Color fundus image — 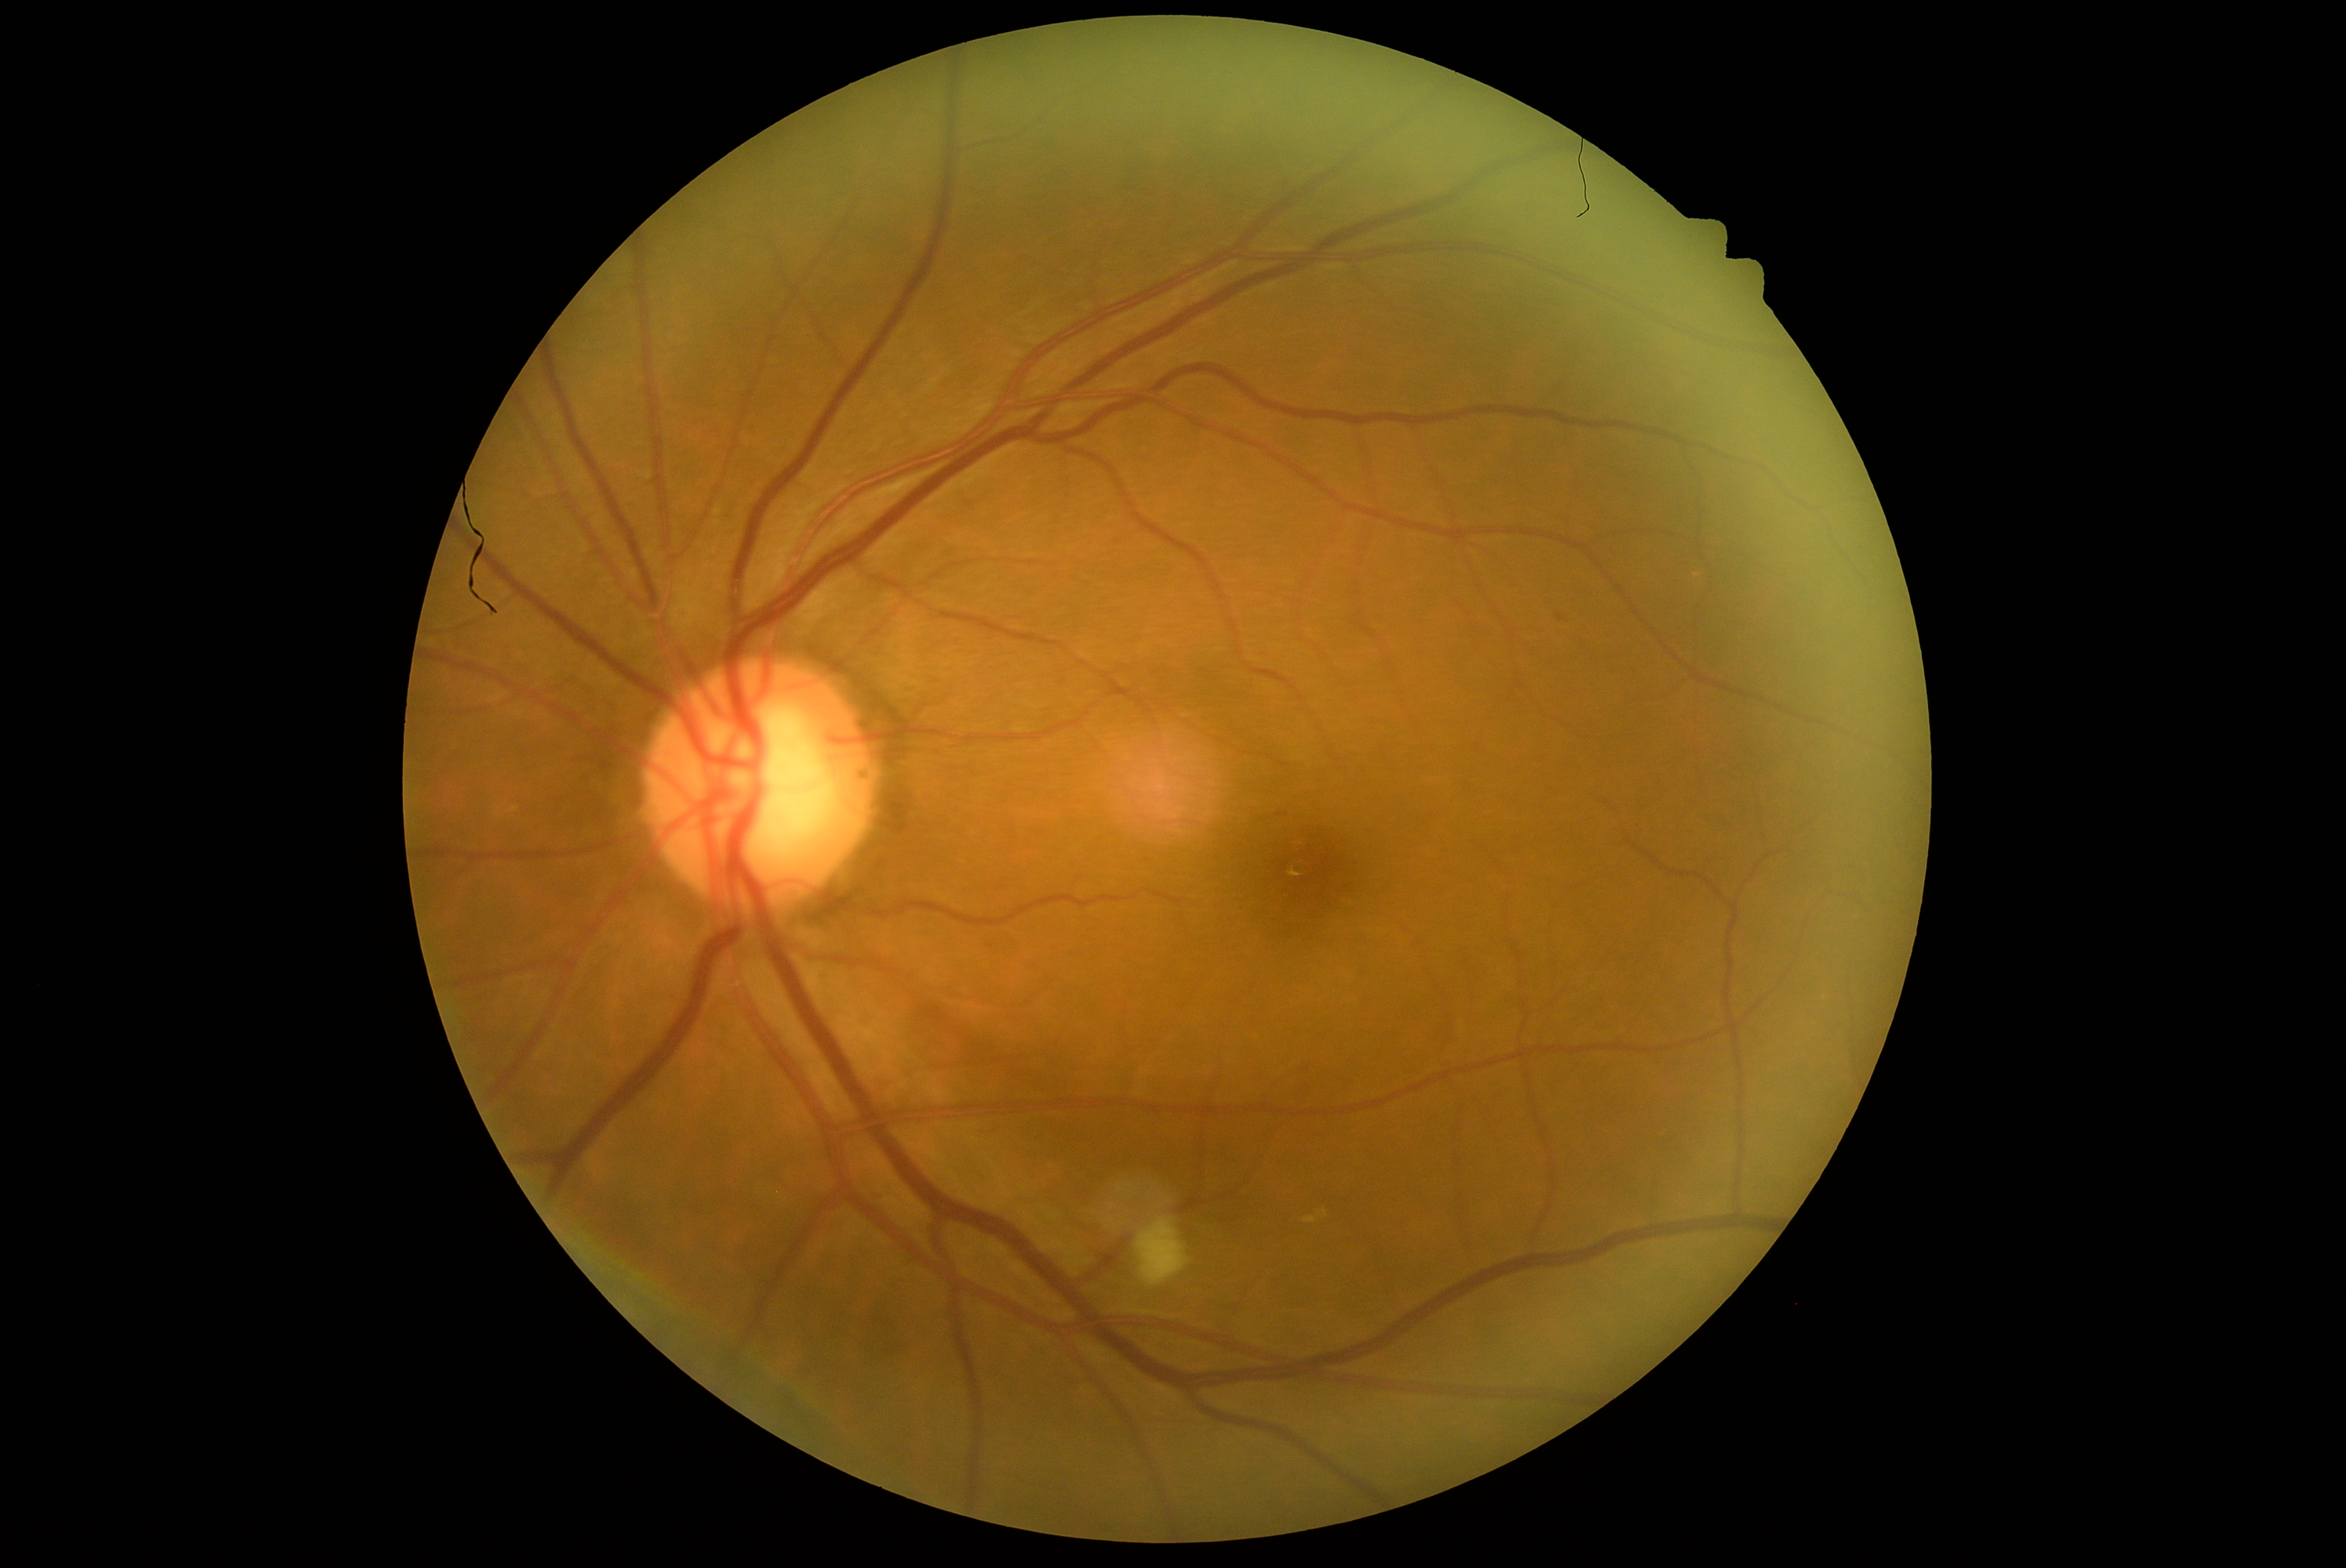

  dr_grade: 2